2352 by 1568 pixels; 45° FOV; CFP: 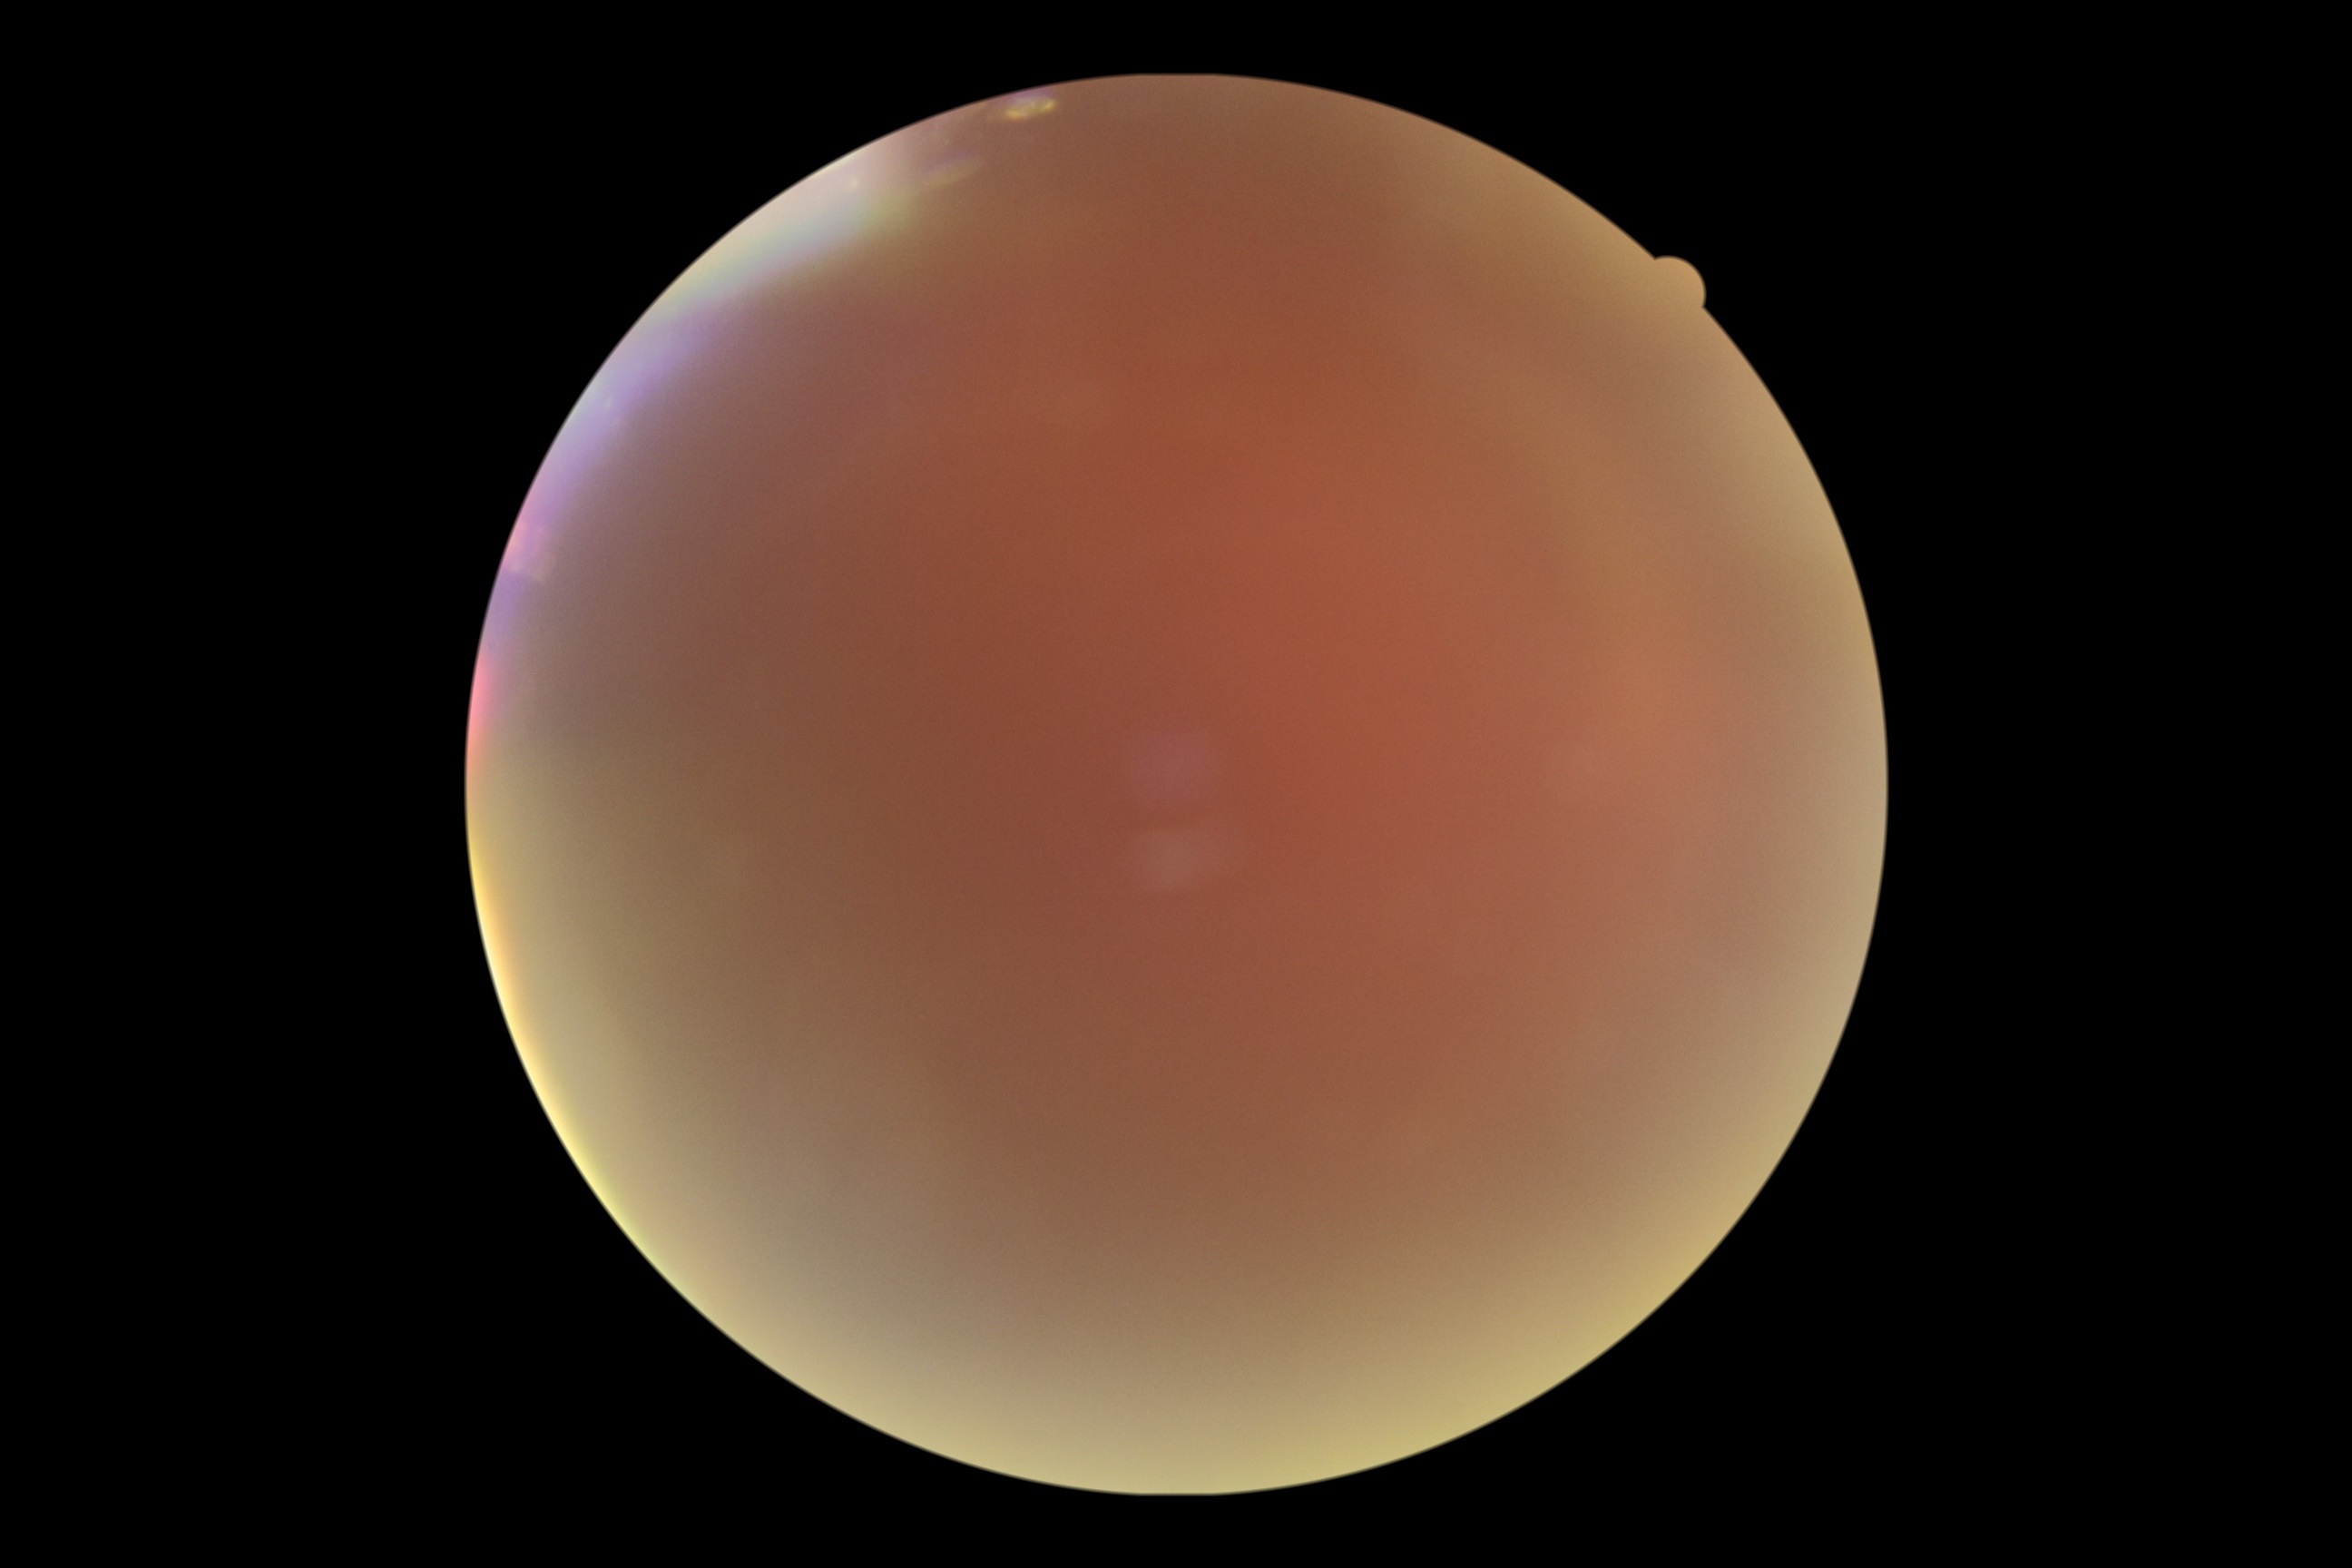 {
  "dr_grade": "ungradable due to poor image quality"
}